Infant wide-field retinal image: 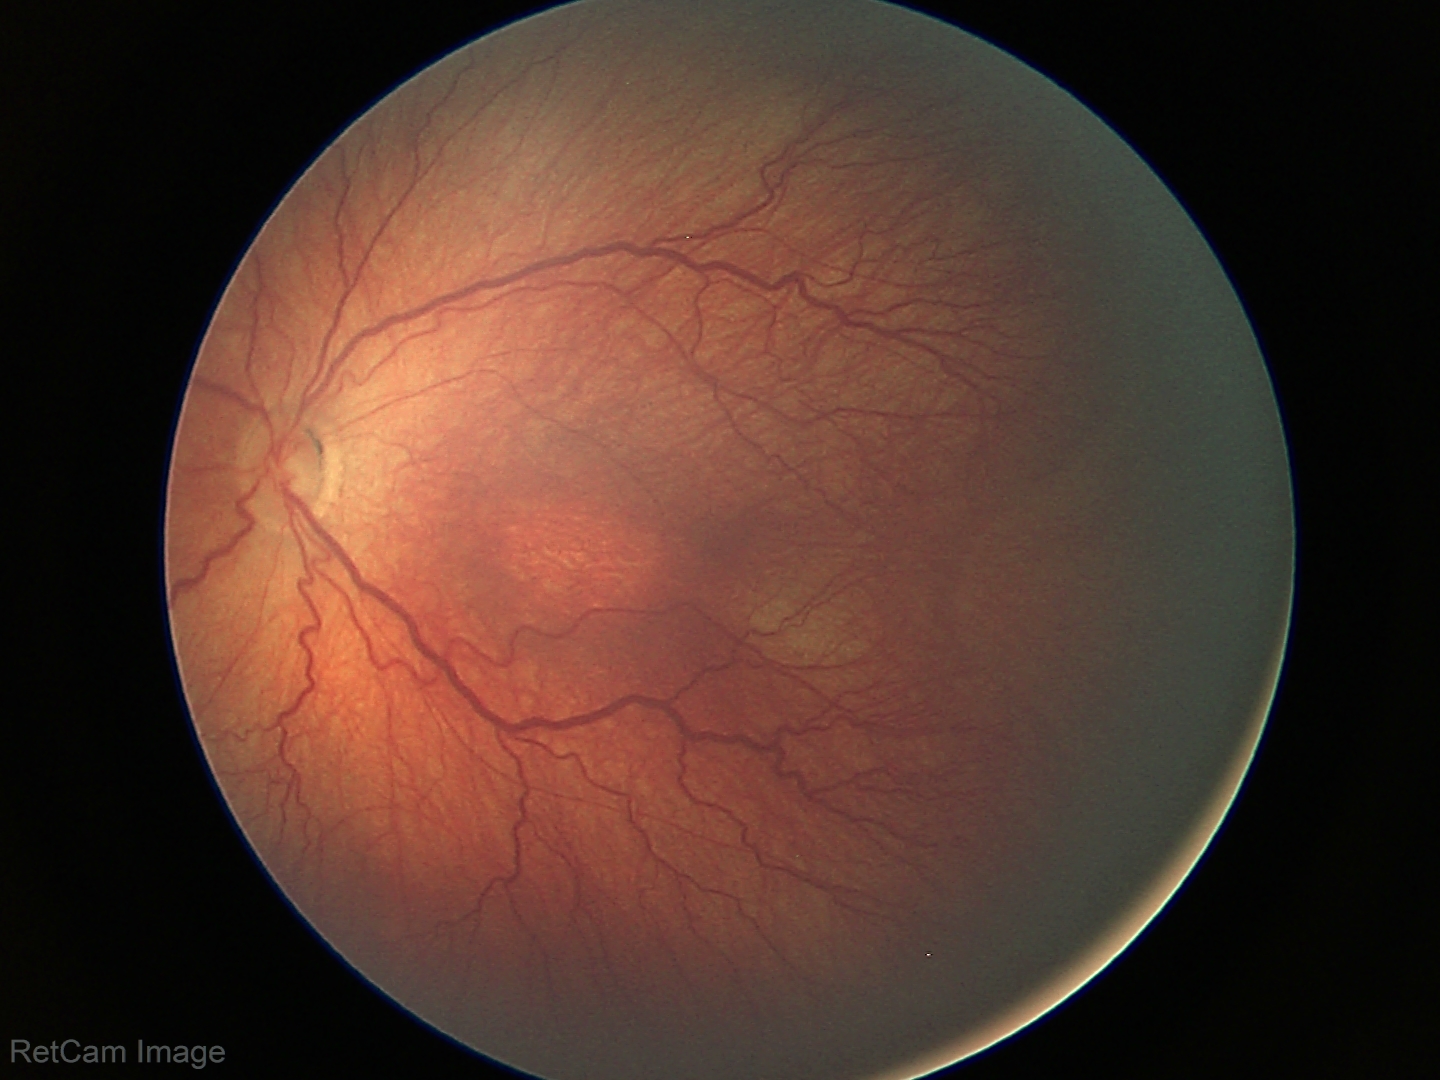
Without plus disease. Series diagnosed as ROP stage 3.